Davis DR grading:
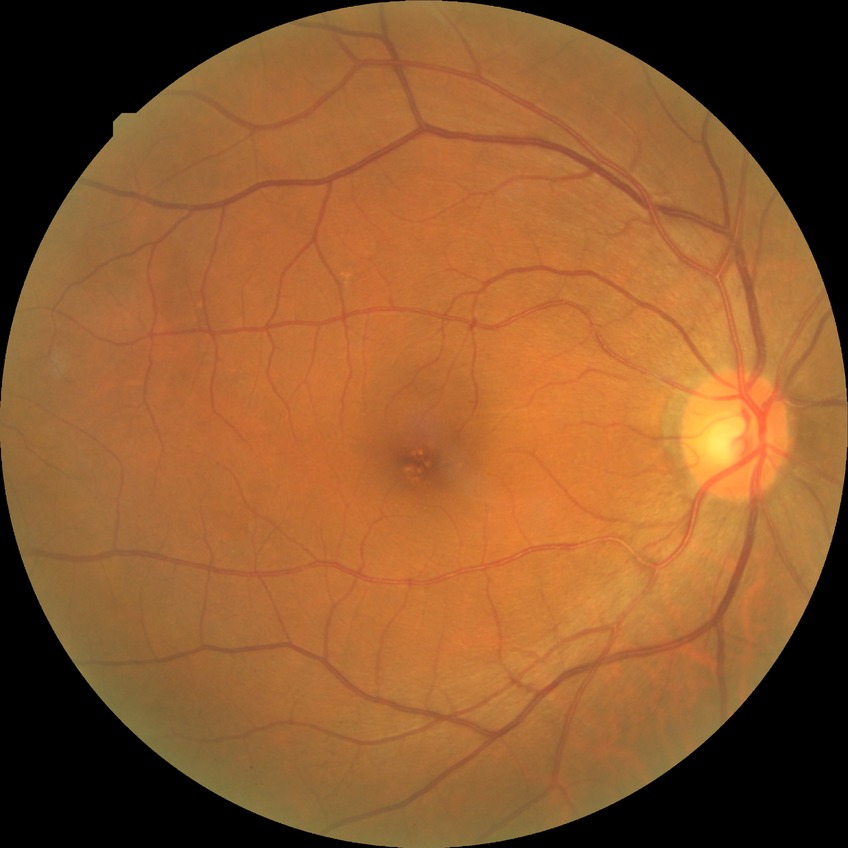
Davis grading: no diabetic retinopathy.